NIDEK AFC-230 fundus camera
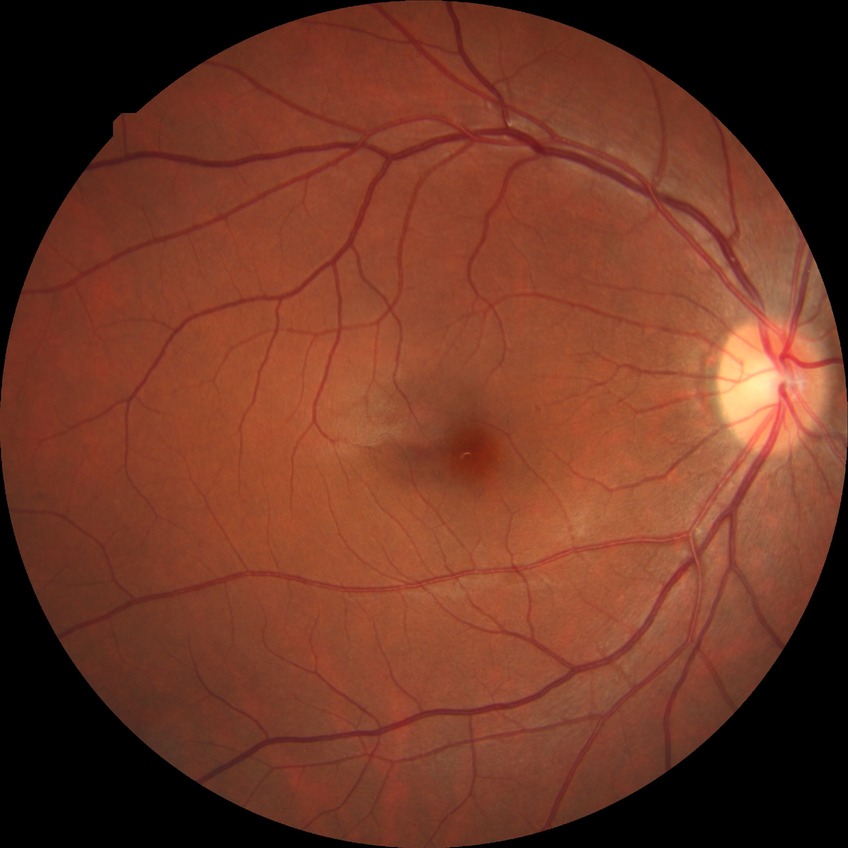
DR class: non-proliferative diabetic retinopathy.
Diabetic retinopathy stage: simple diabetic retinopathy.